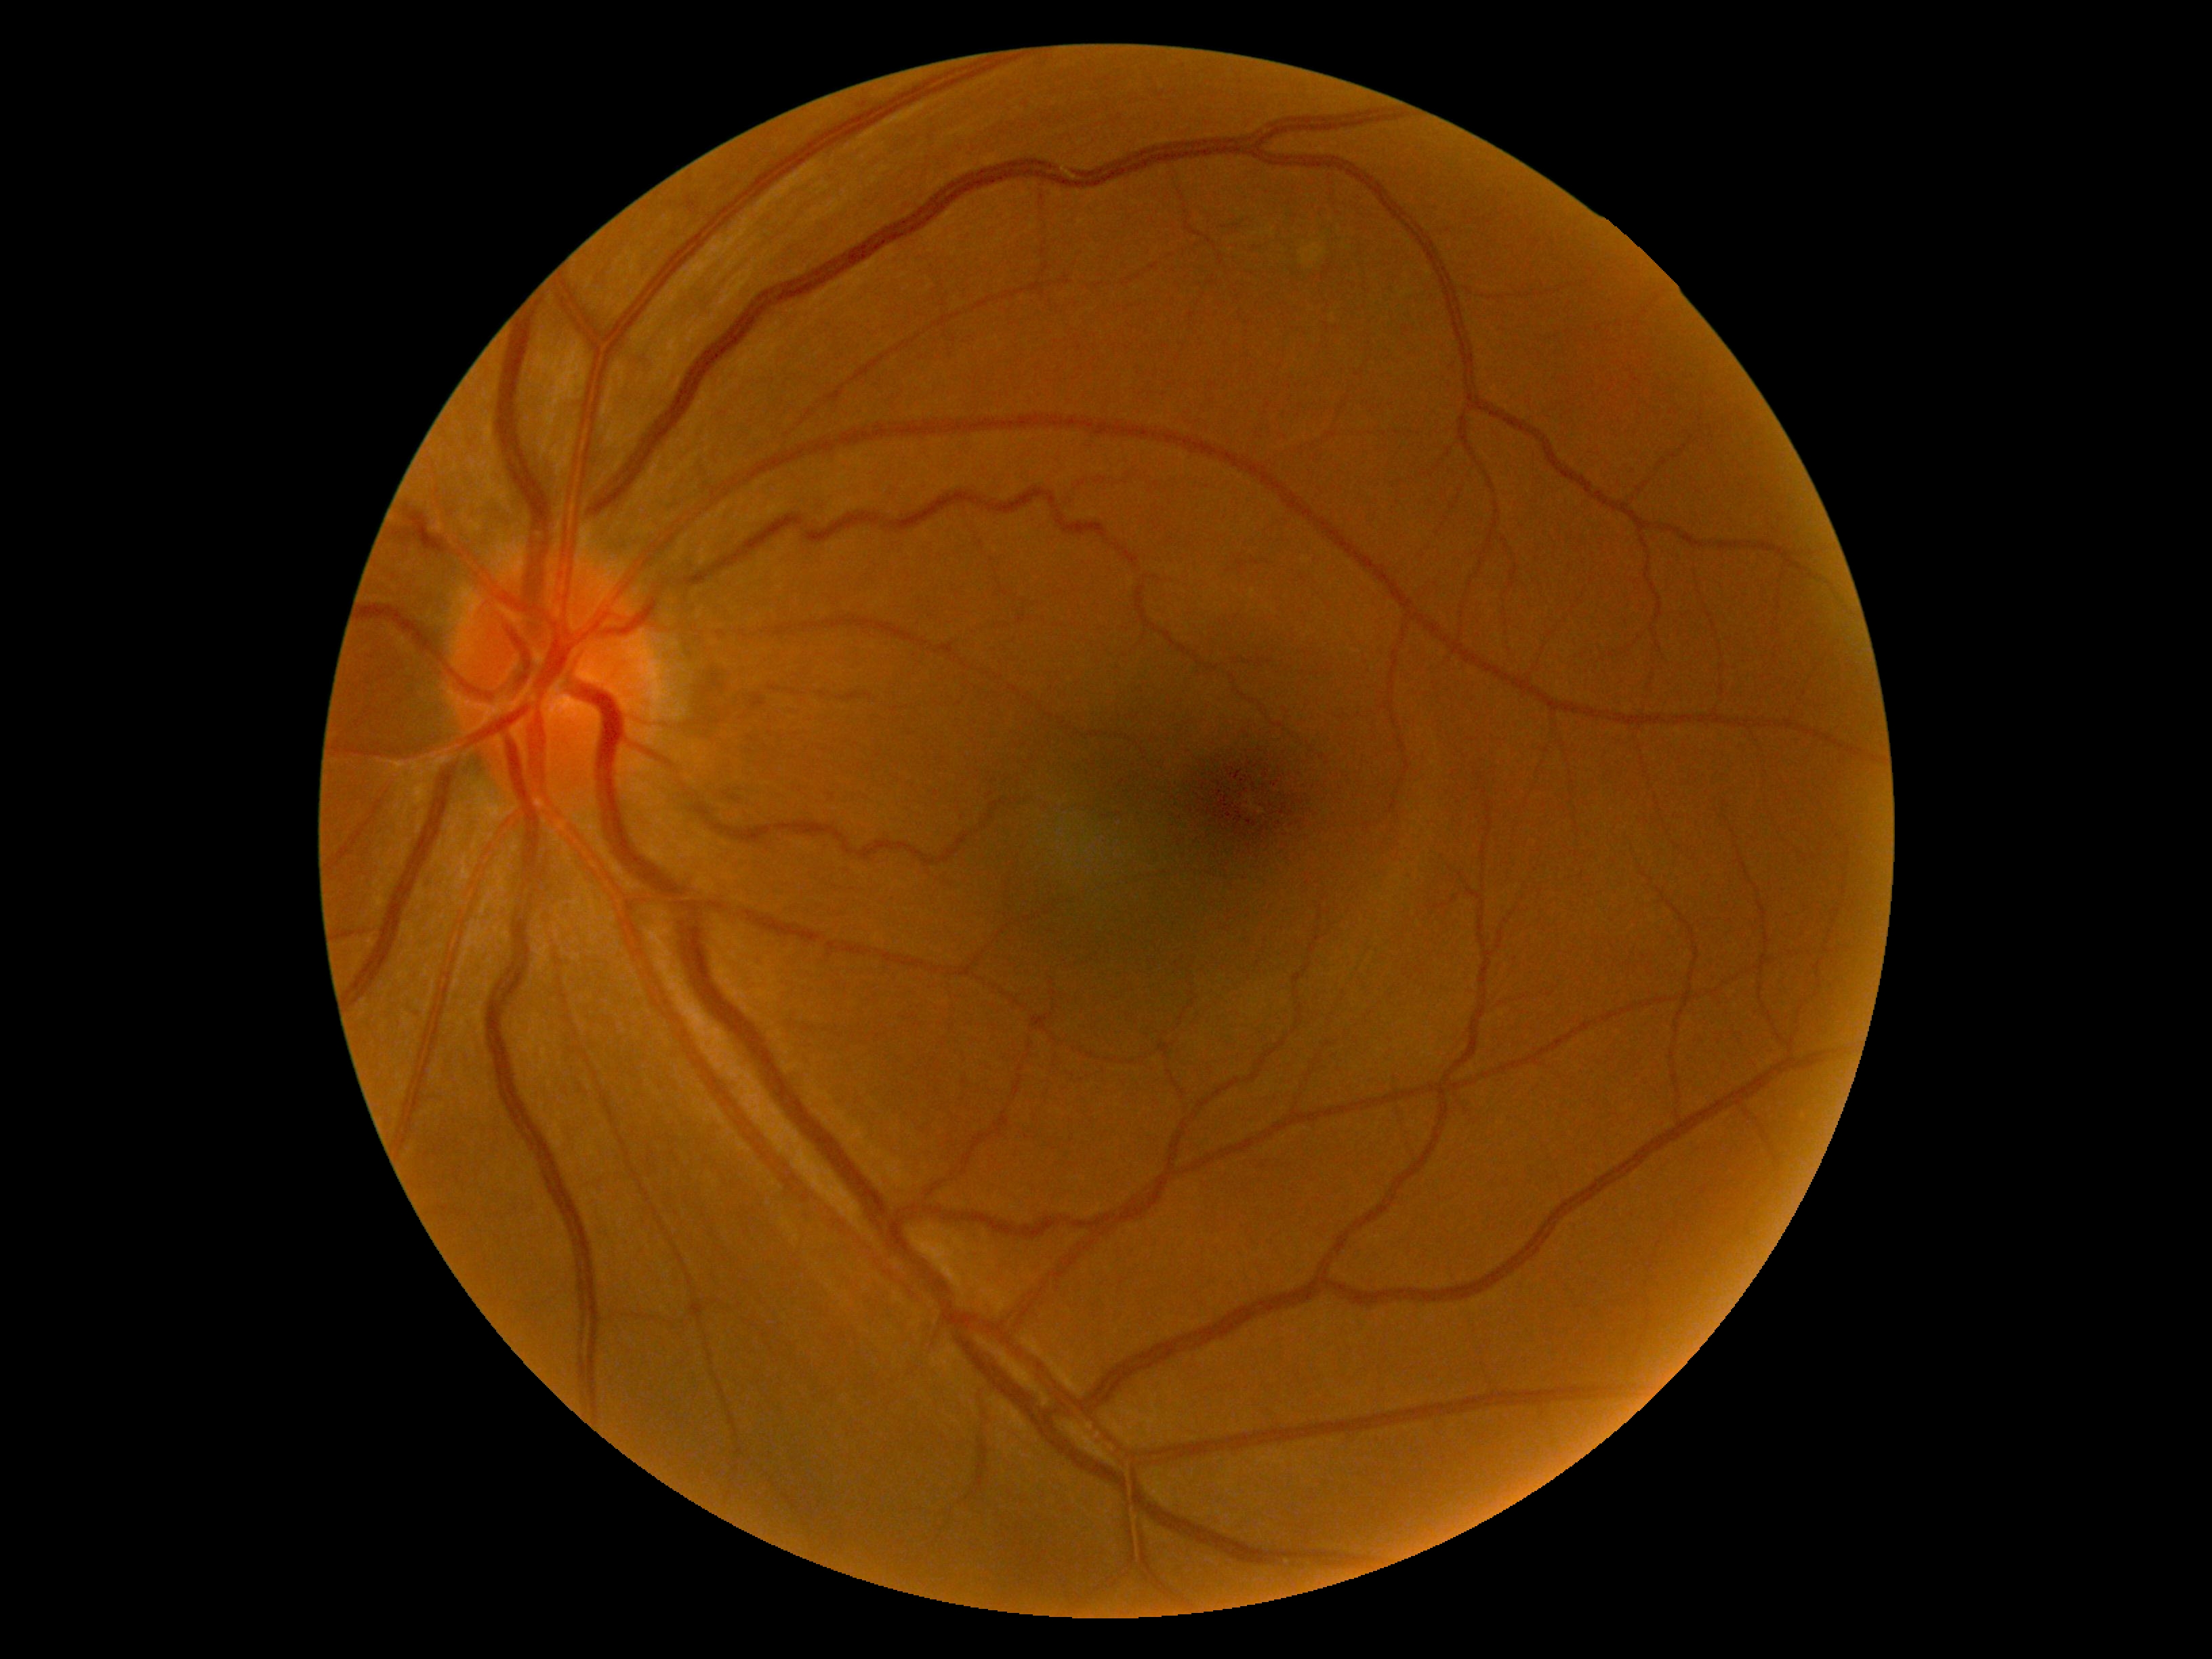

Findings:
- diabetic retinopathy severity: 0/4